Captured with the Phoenix ICON (100° field of view). Infant wide-field retinal image.
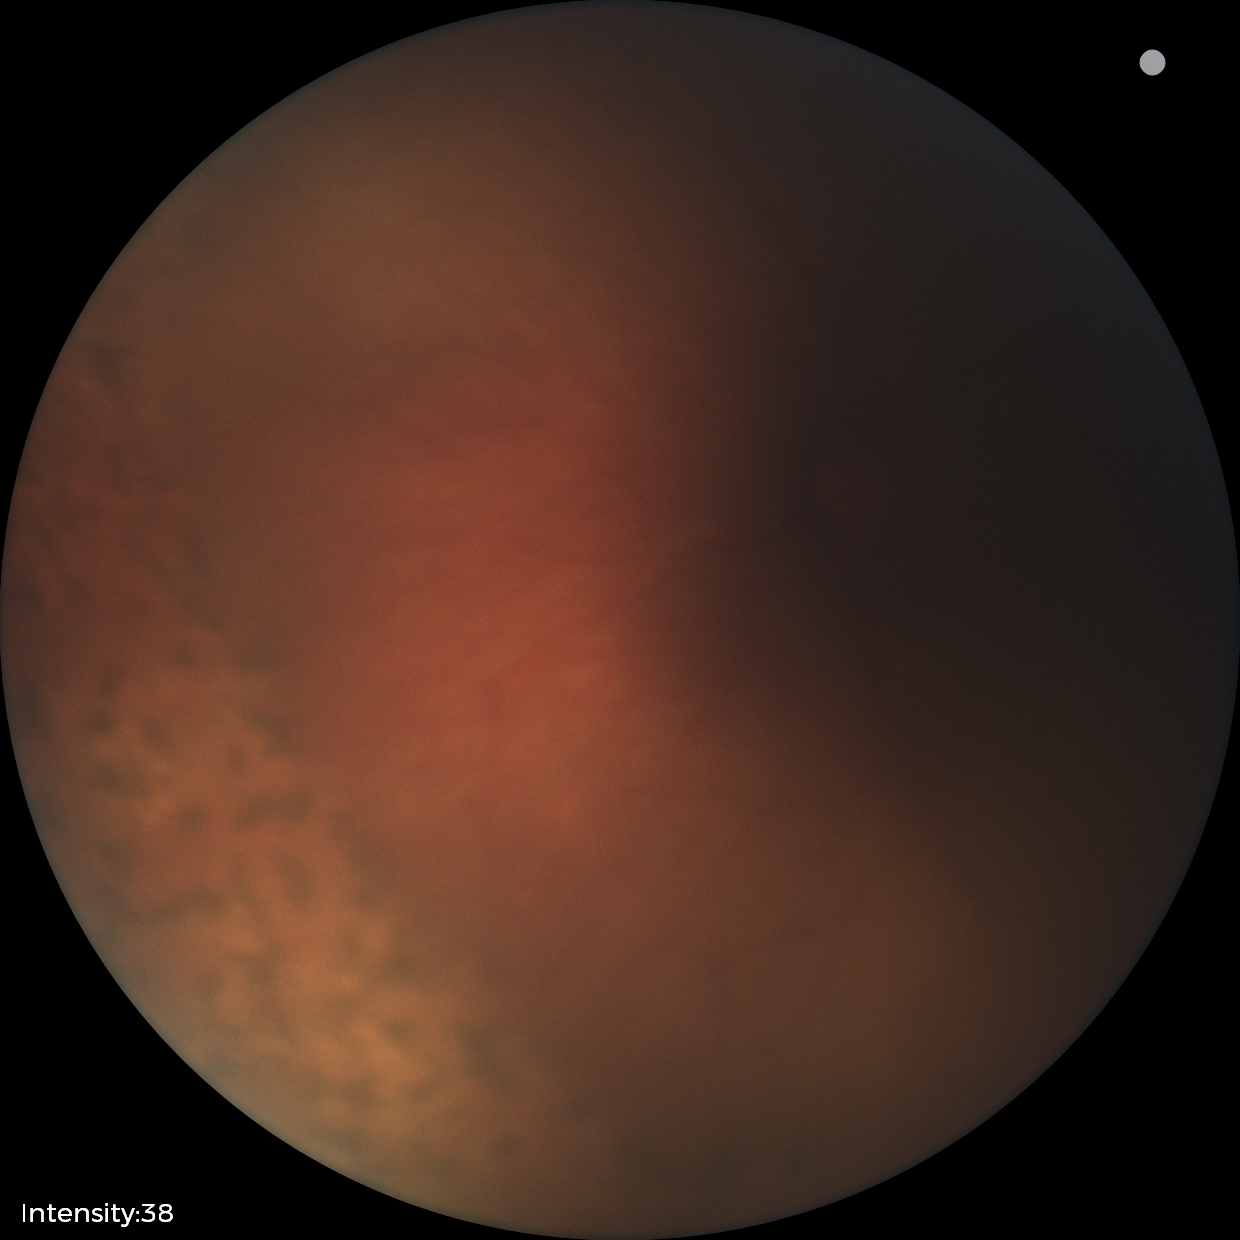 Plus disease absent.
Screening examination consistent with status post ROP.